848x848px.
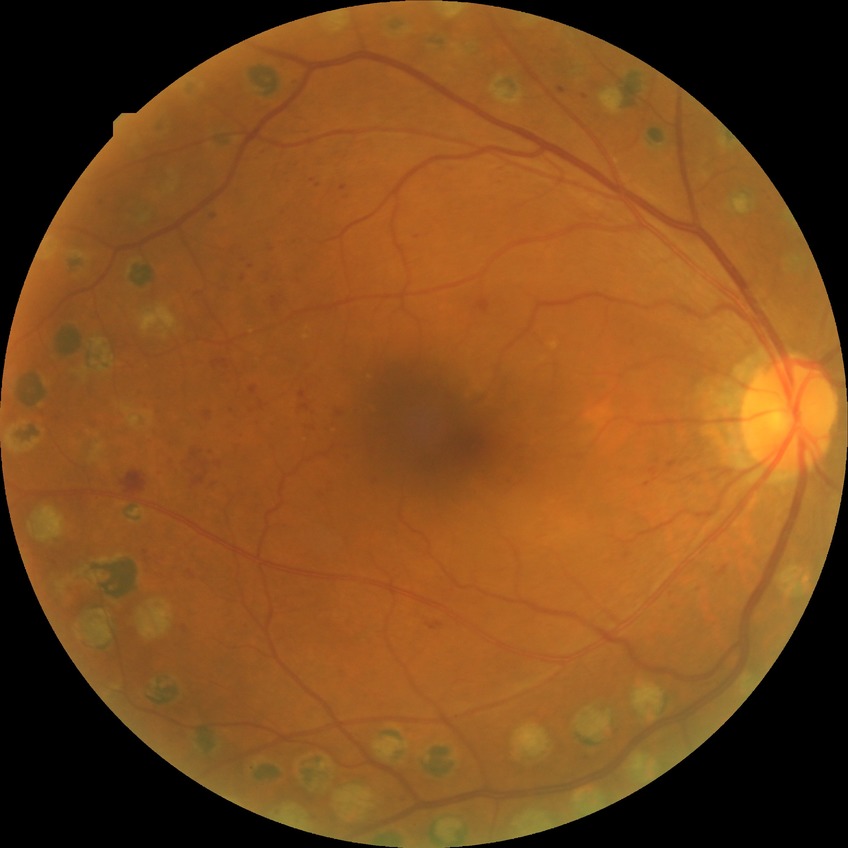 Diabetic retinopathy (DR) is proliferative diabetic retinopathy (PDR).